1932x1916px; color fundus image: 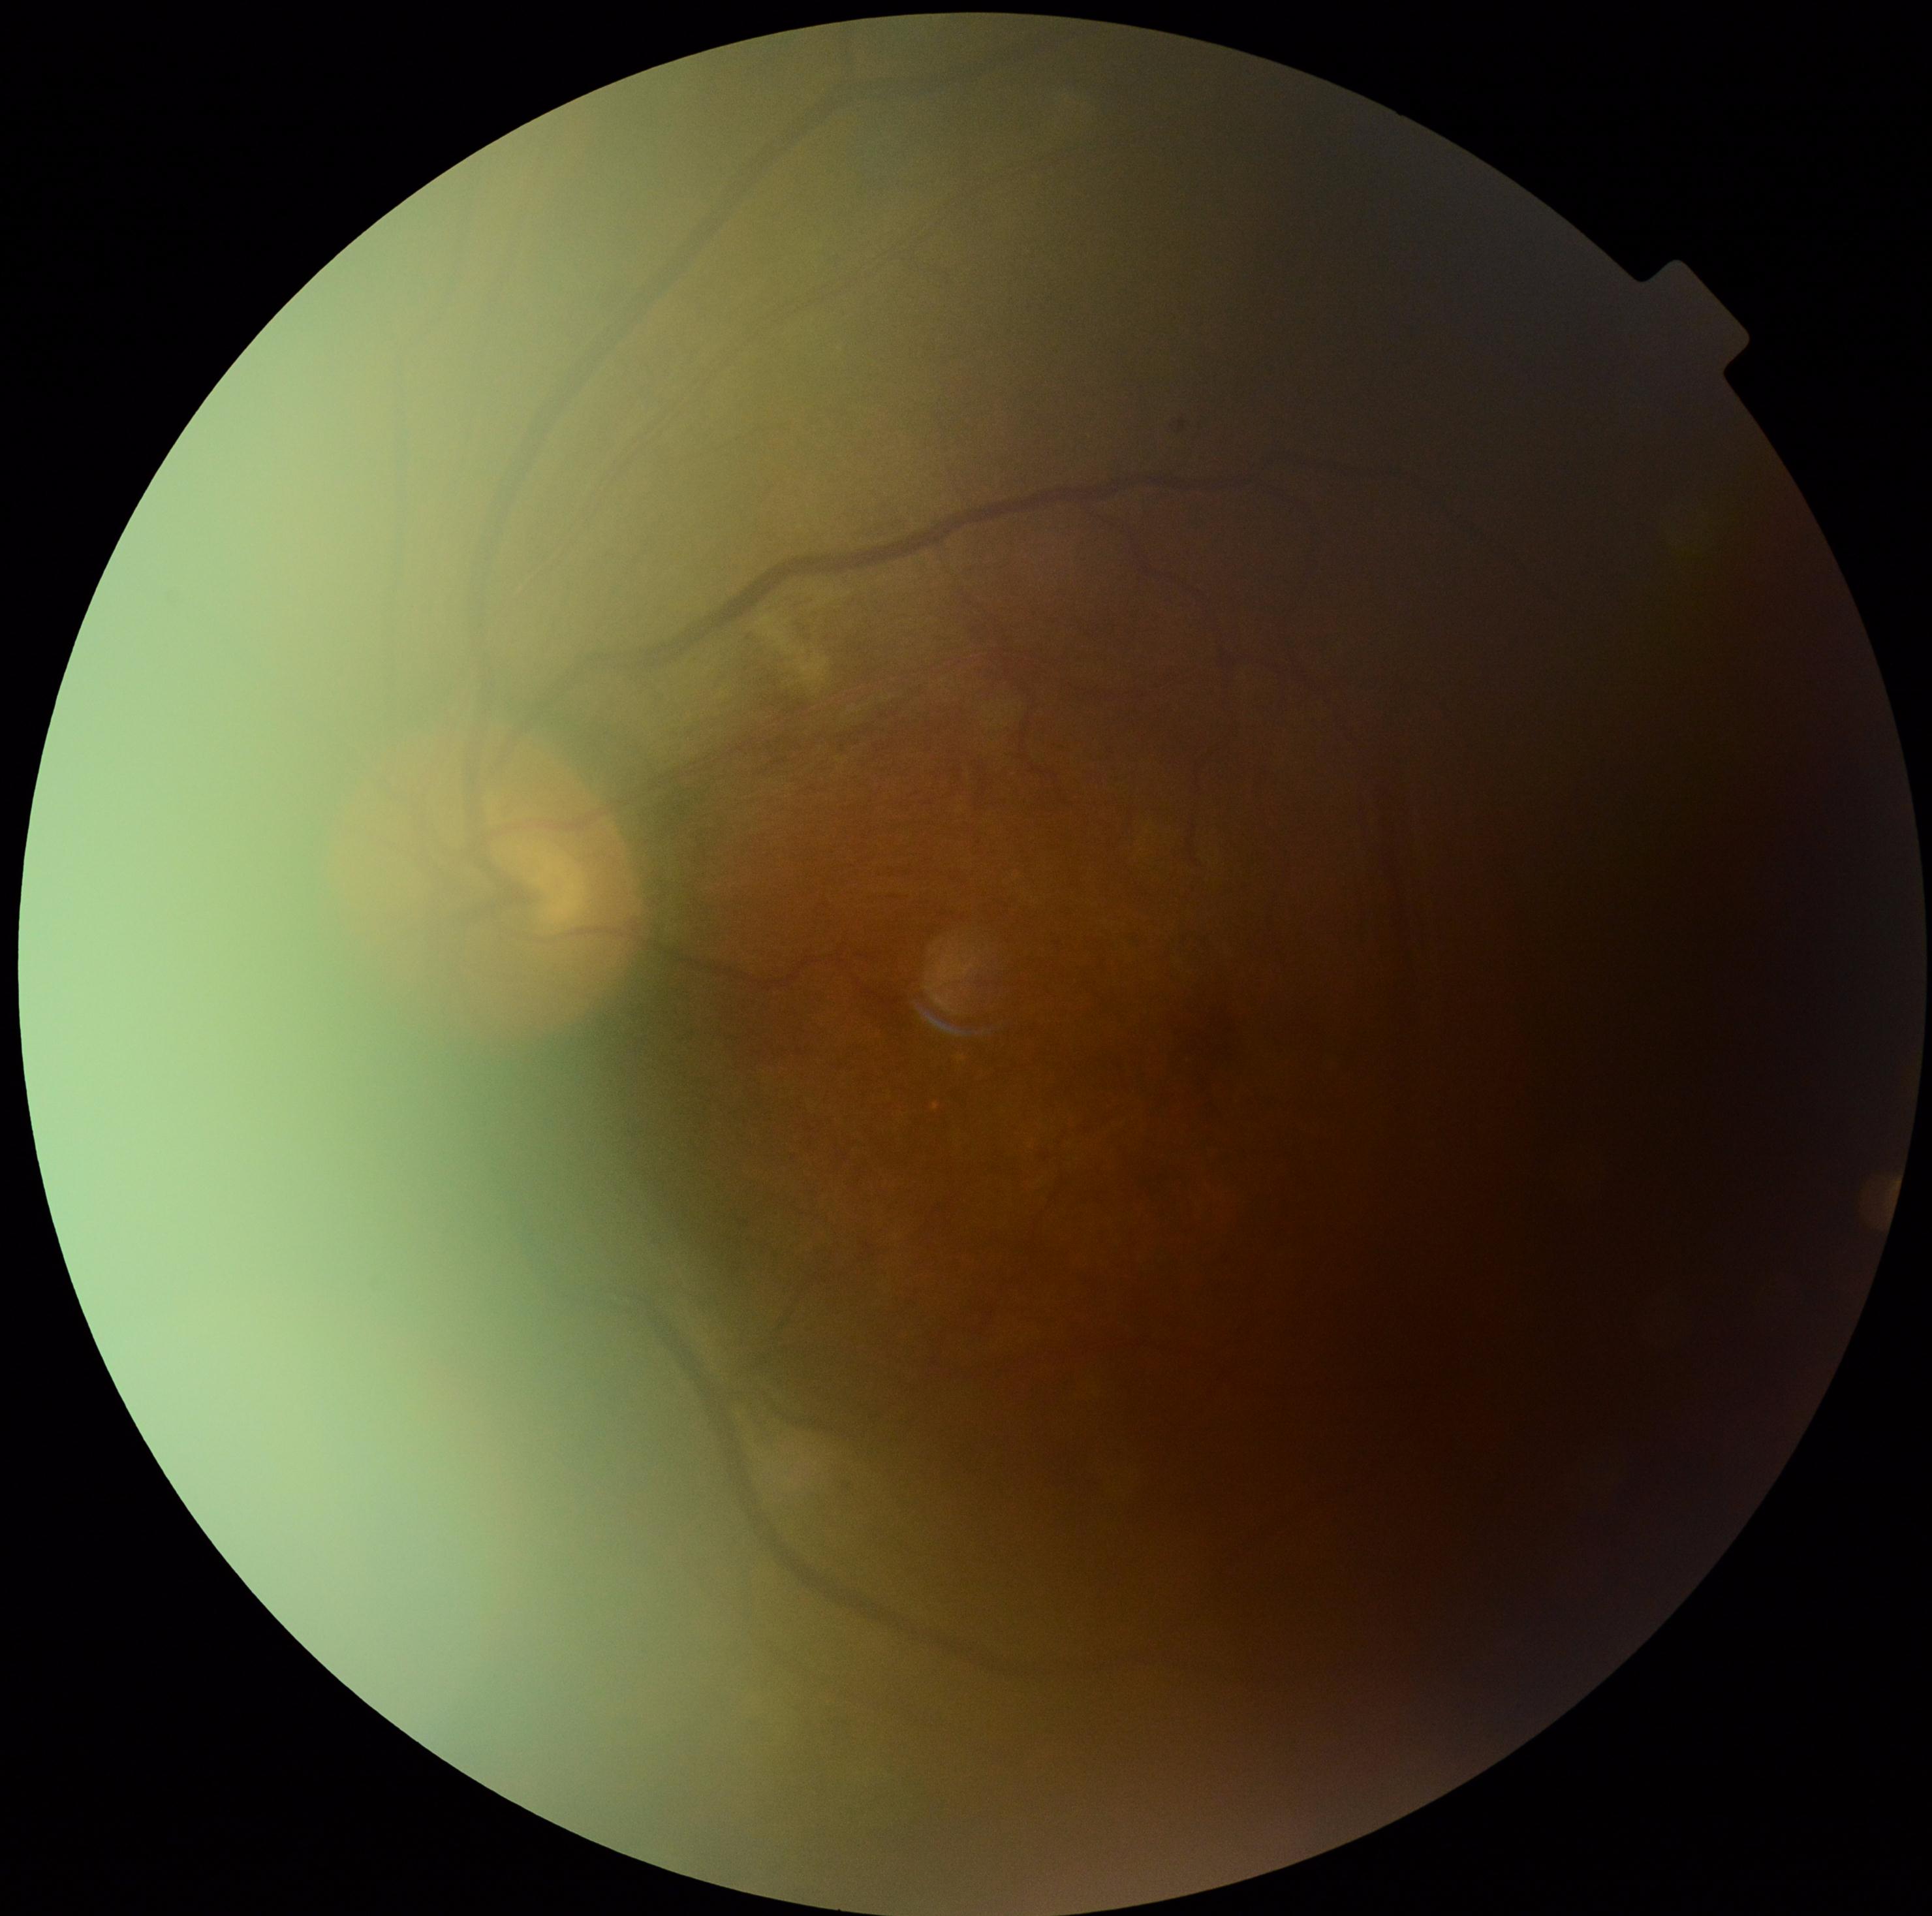

DR class: non-proliferative diabetic retinopathy | diabetic retinopathy severity: grade 2 (moderate NPDR).